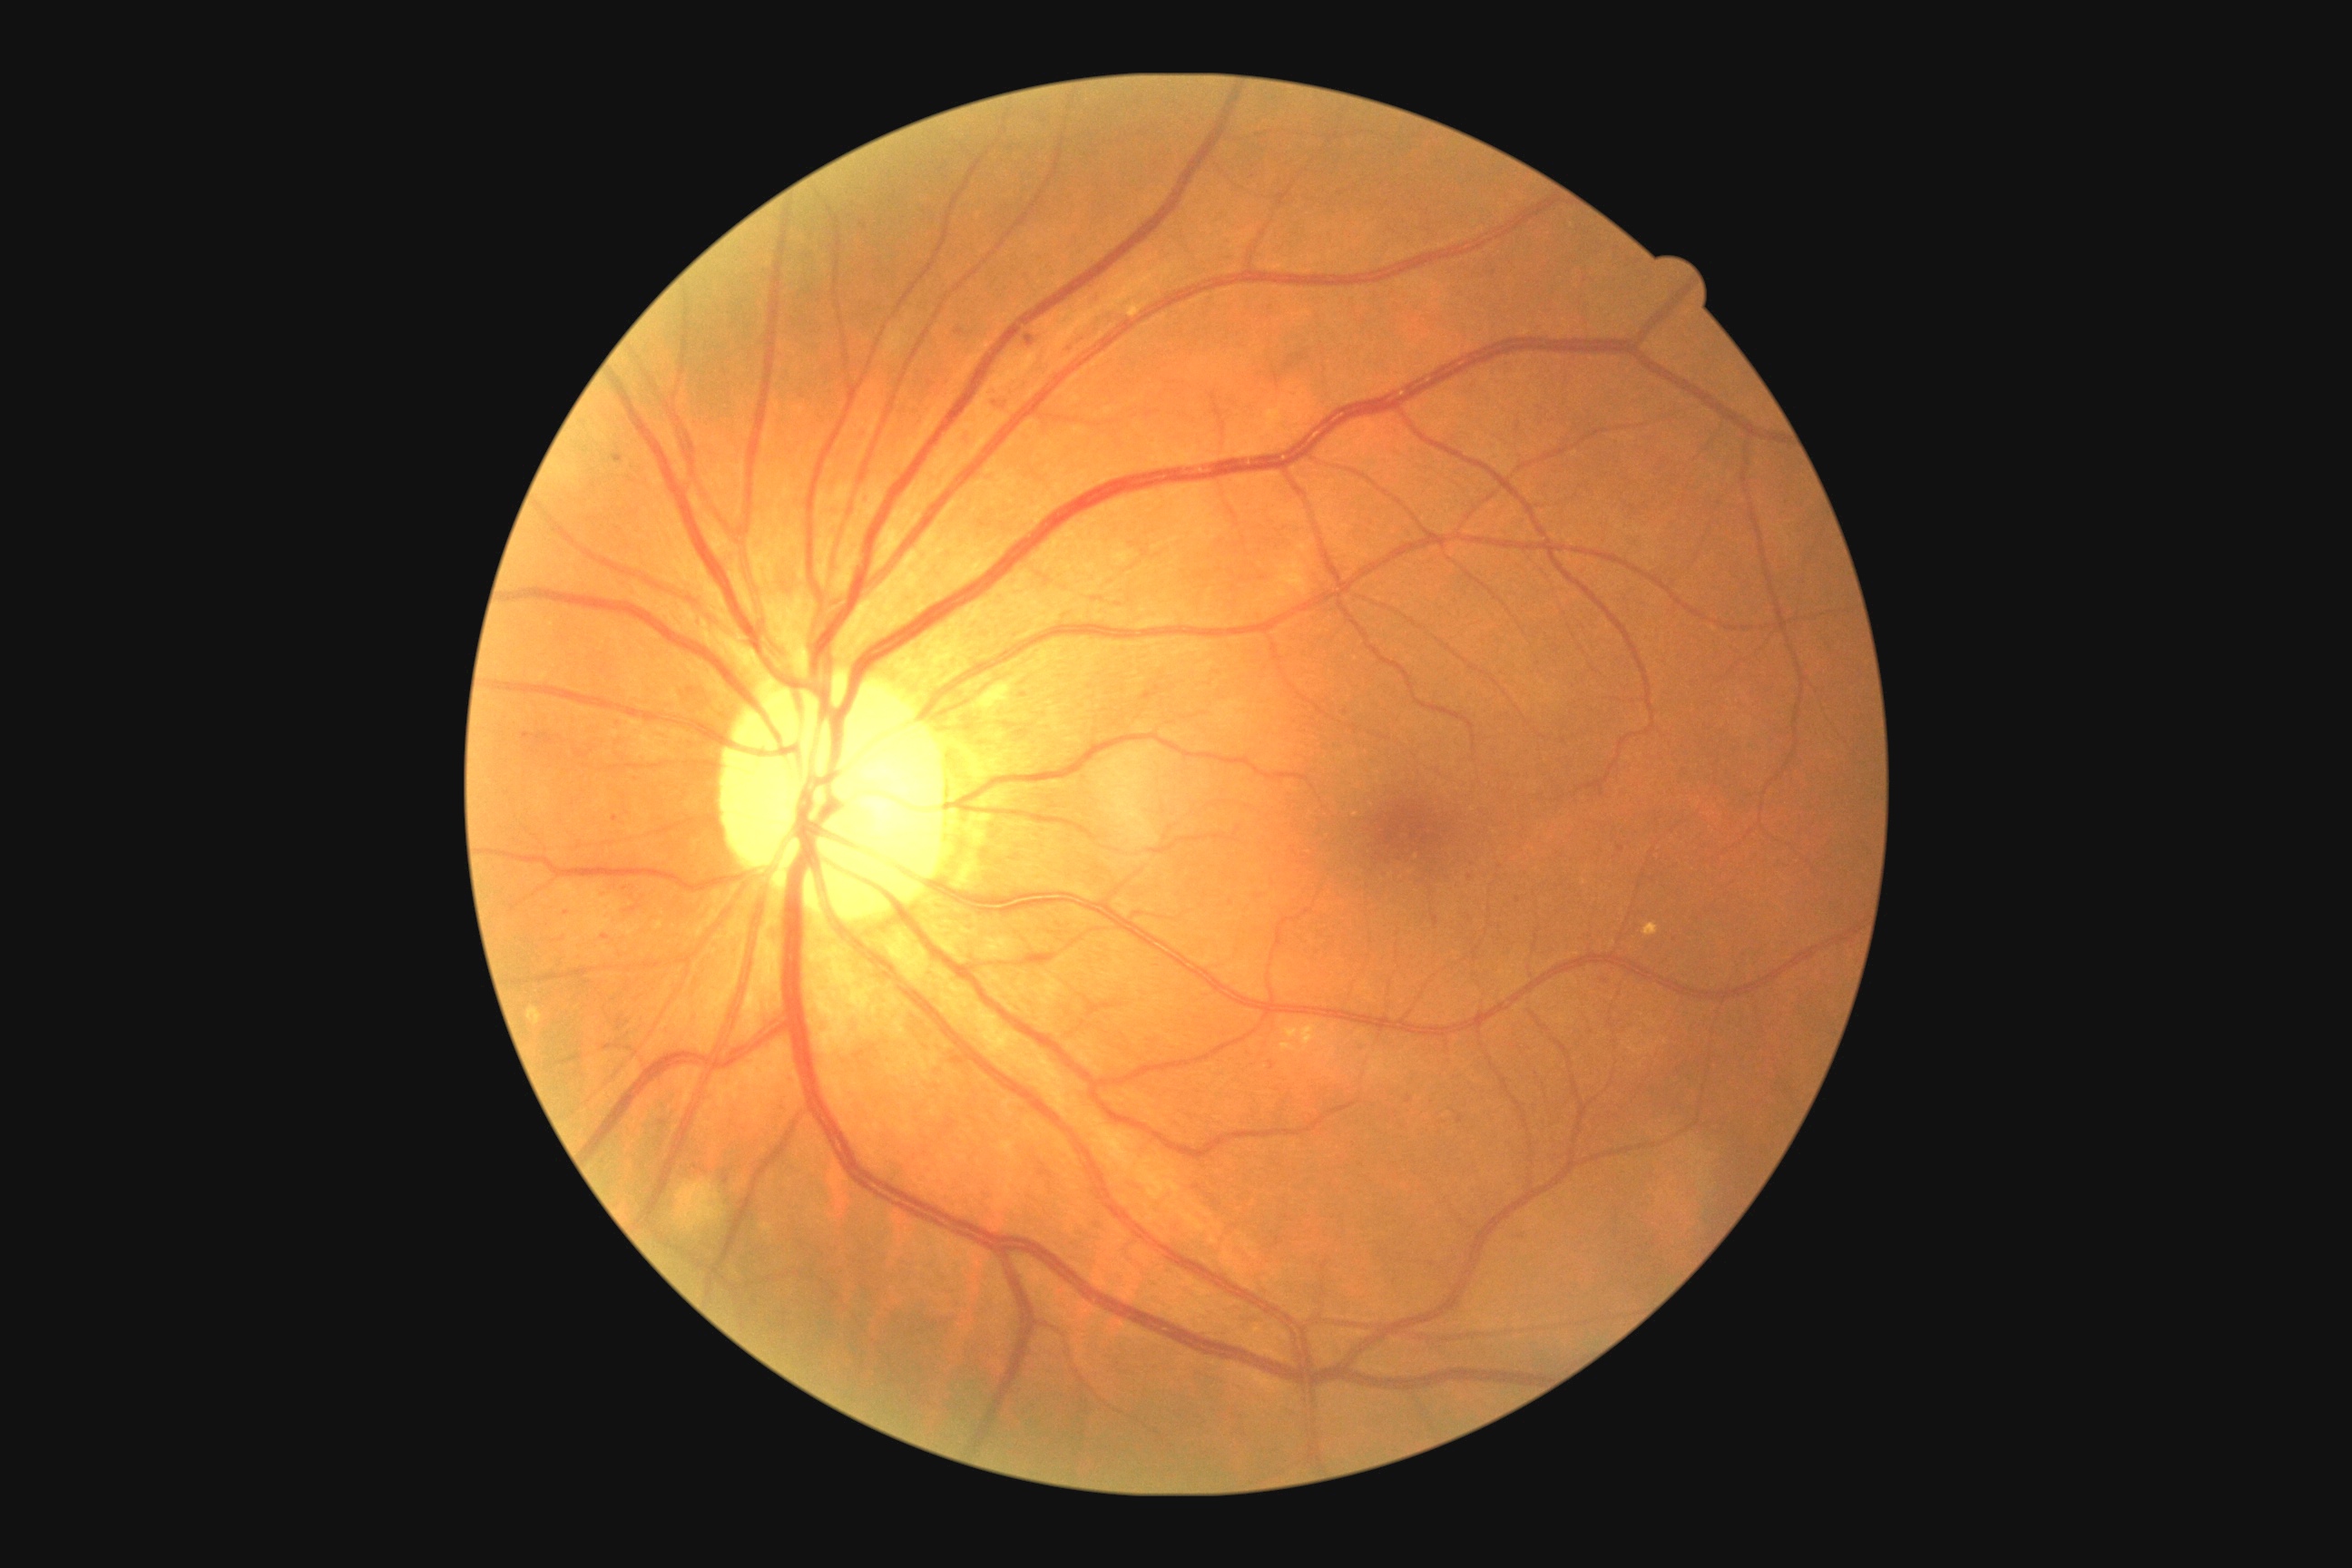

Diabetic retinopathy (DR) is 2; non-proliferative diabetic retinopathy.
Hard exudates (EXs) found at 1280:1024:1318:1055; 527:1006:544:1026.
Soft exudates (SEs) found at 1255:554:1309:607; 676:1179:725:1233; 1113:551:1133:567.
No hemorrhages (HEs) identified.
Microaneurysms (MAs) include lesions at 614:455:623:462; 1068:342:1075:353; 859:431:867:442; 1142:692:1153:701; 992:398:1010:411.
MAs (small, approximate centers) near [567, 914]; [1272, 1066]; [1410, 1099]; [1500, 866]; [615, 818]; [1620, 849]; [605, 938].